45-degree field of view:
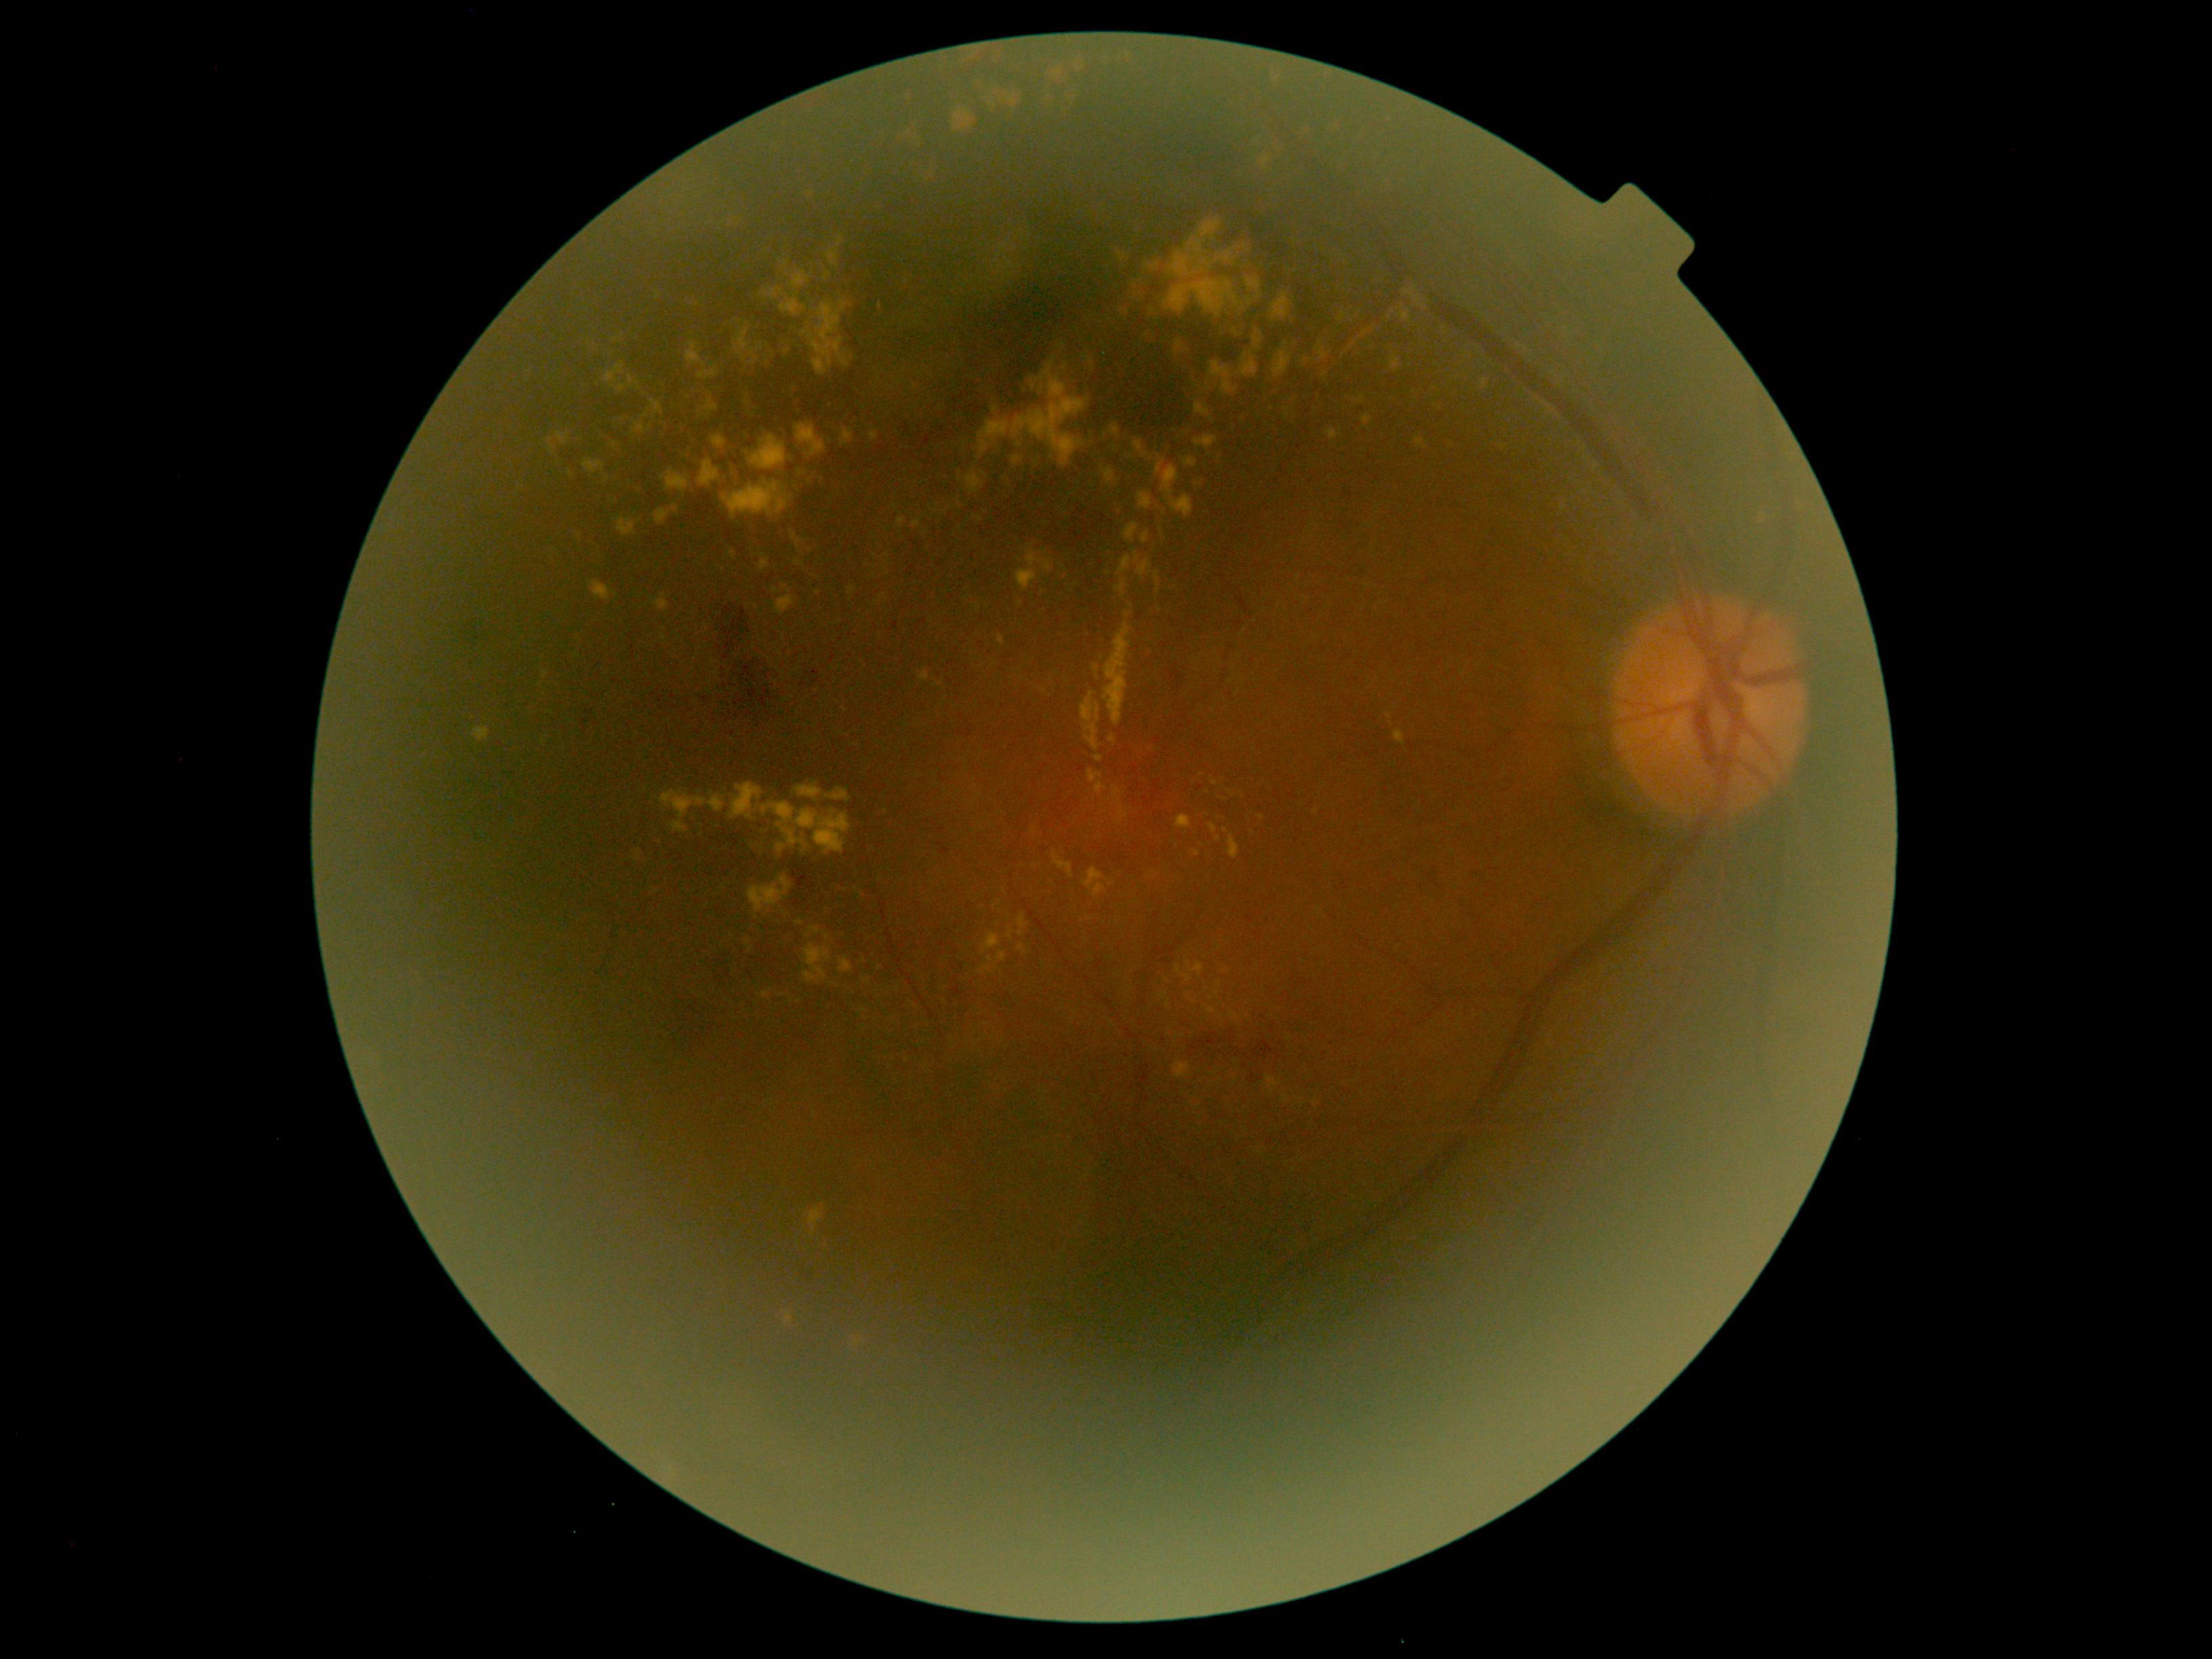 DR severity: 2/4
Lesions identified (partial list):
EXs (continued) = (1272,293,1292,319); (823,274,832,280); (1197,220,1221,237); (1084,868,1107,899); (848,586,857,596); (998,635,1004,646); (1168,241,1212,280); (635,851,642,861); (1116,579,1127,598); (794,533,802,548); (1394,730,1405,745); (1118,555,1131,575)
Additional small EXs near 867/982; 1037/464; 1217/992; 665/637; 1064/514; 800/472; 697/659